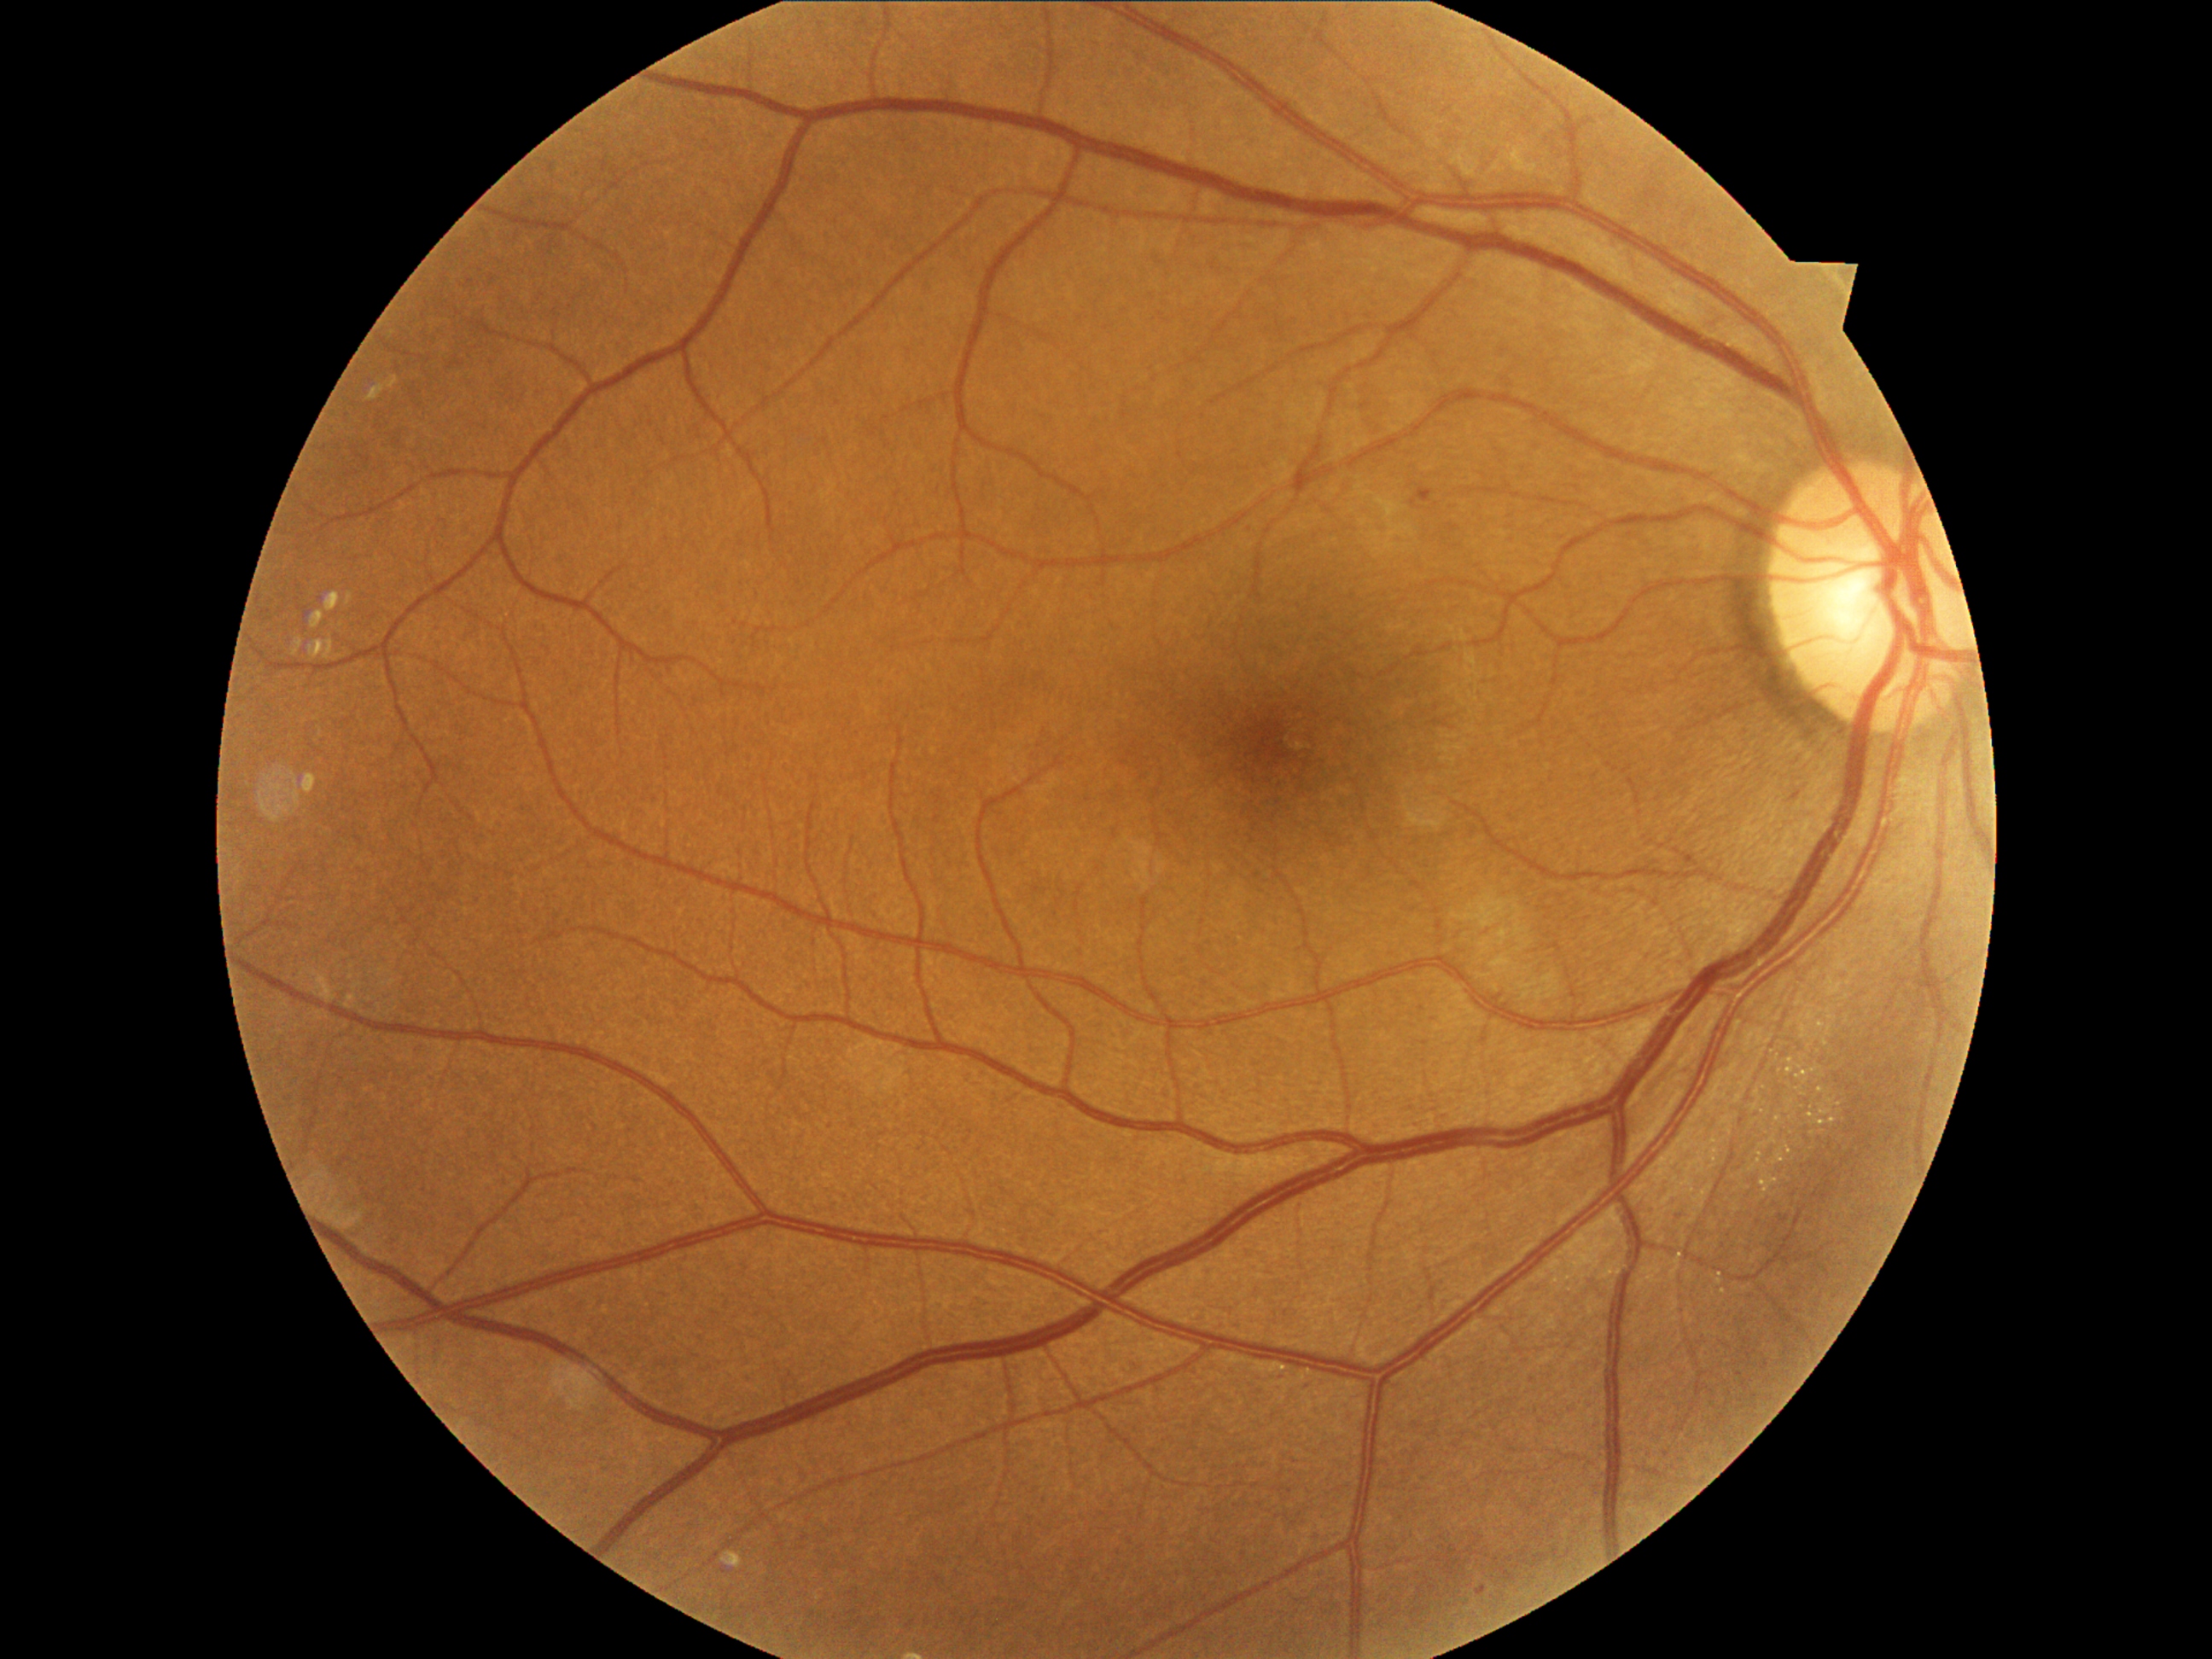

Diabetic retinopathy (DR) is moderate NPDR (grade 2)
Lesions identified (partial list):
hemorrhages (HEs): none
microaneurysms (MAs) (subset): box=[1477, 1585, 1489, 1595]; box=[1416, 489, 1433, 504]
soft exudates (SEs) (subset): box=[1453, 888, 1511, 929]; box=[1511, 900, 1535, 953]; box=[1481, 929, 1511, 957]; box=[1491, 953, 1518, 975]; box=[1518, 972, 1563, 1001]; box=[1479, 974, 1491, 979]
Small SEs near 1526/968; 1537/1007; 1496/988; 1586/883
hard exudates (EXs): none